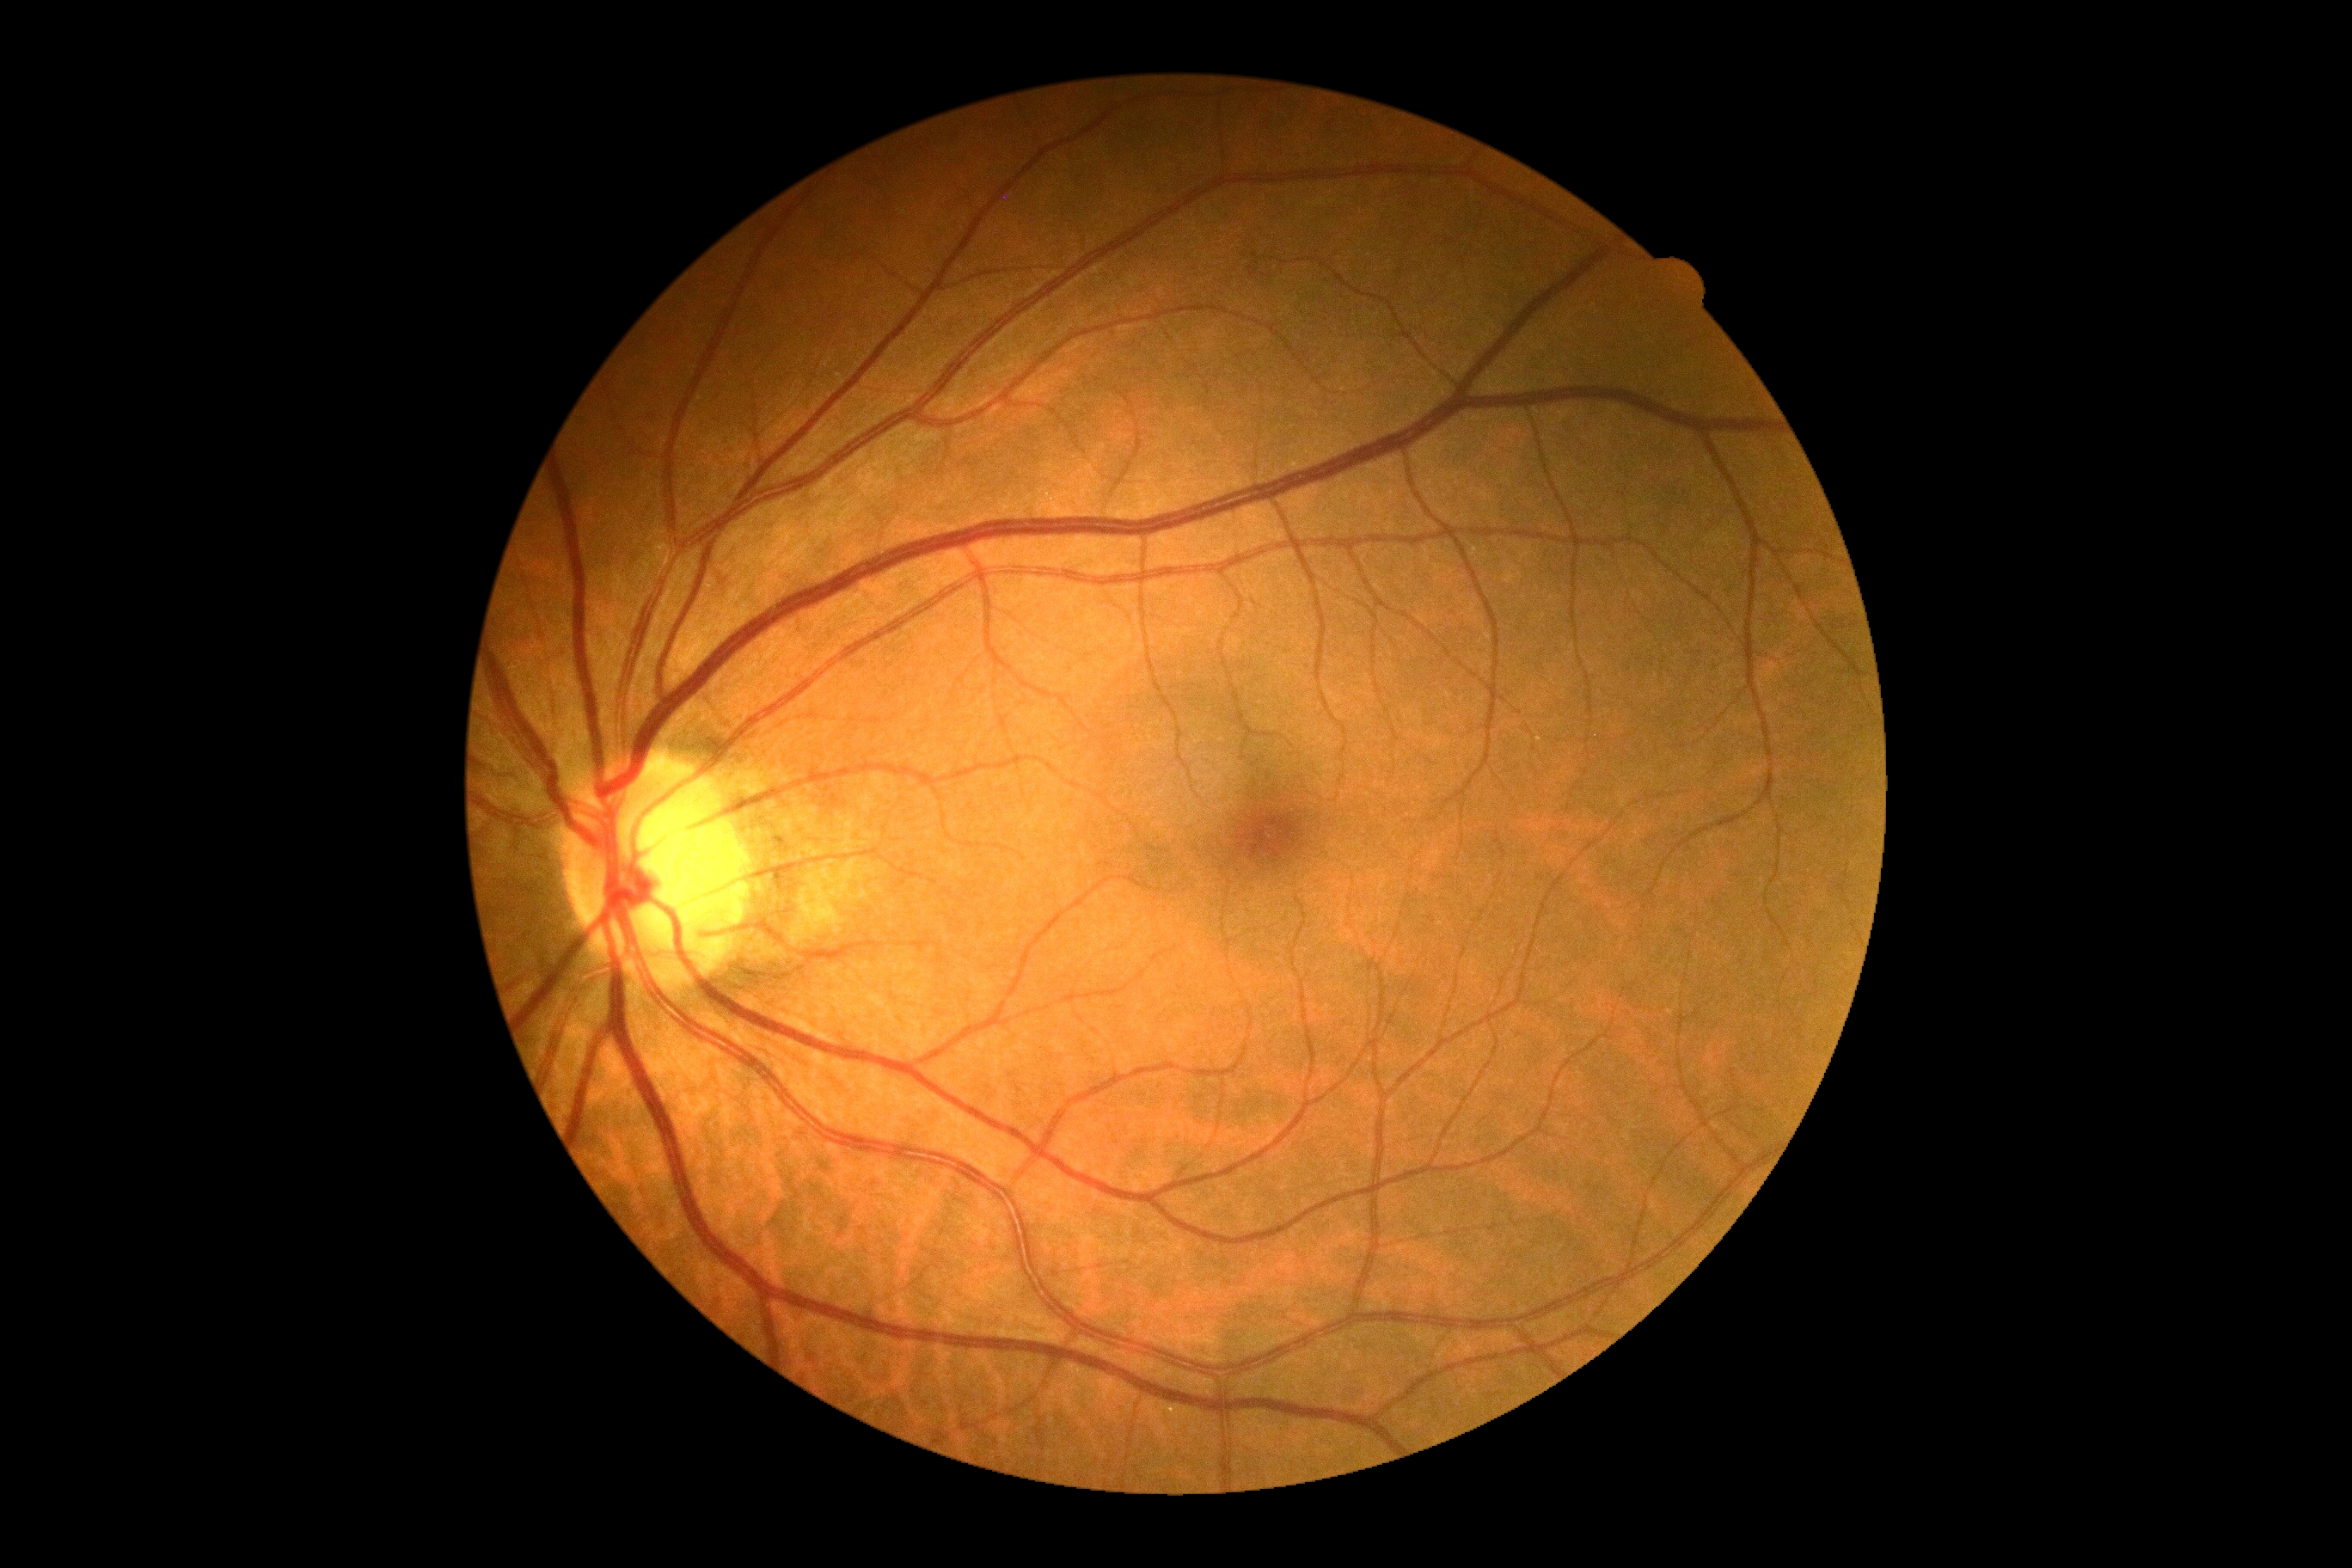

DR stage is grade 0 (no apparent retinopathy).